CFP. No pharmacologic dilation
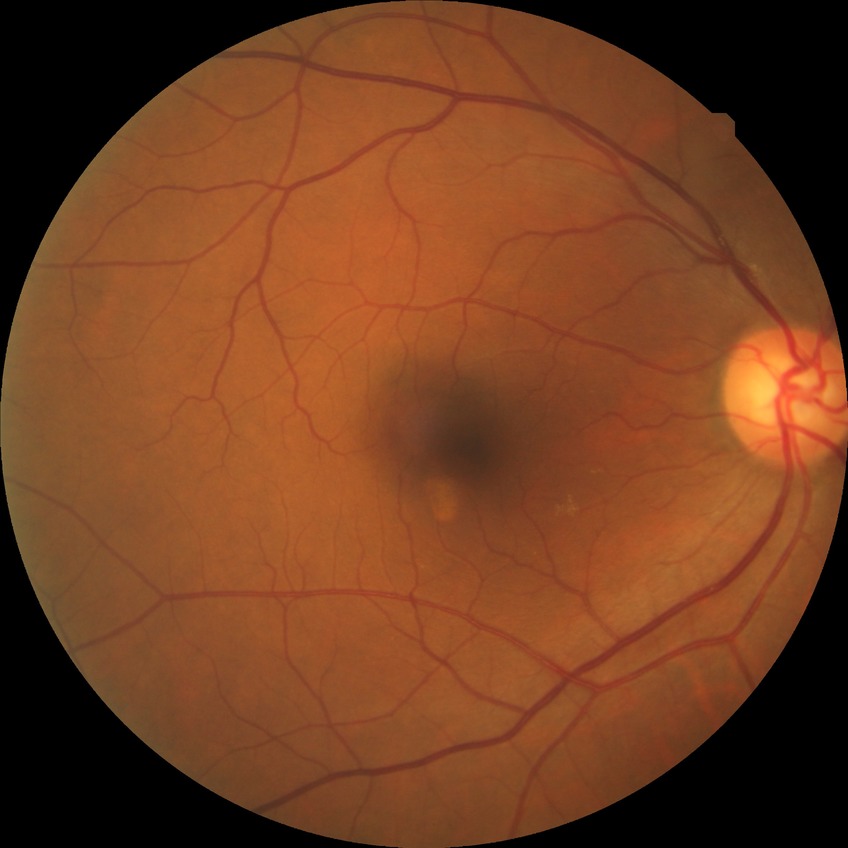
DR severity = NDR | DR impression = no apparent DR.